Fundus photo; image size 2352x1568; 45° FOV: 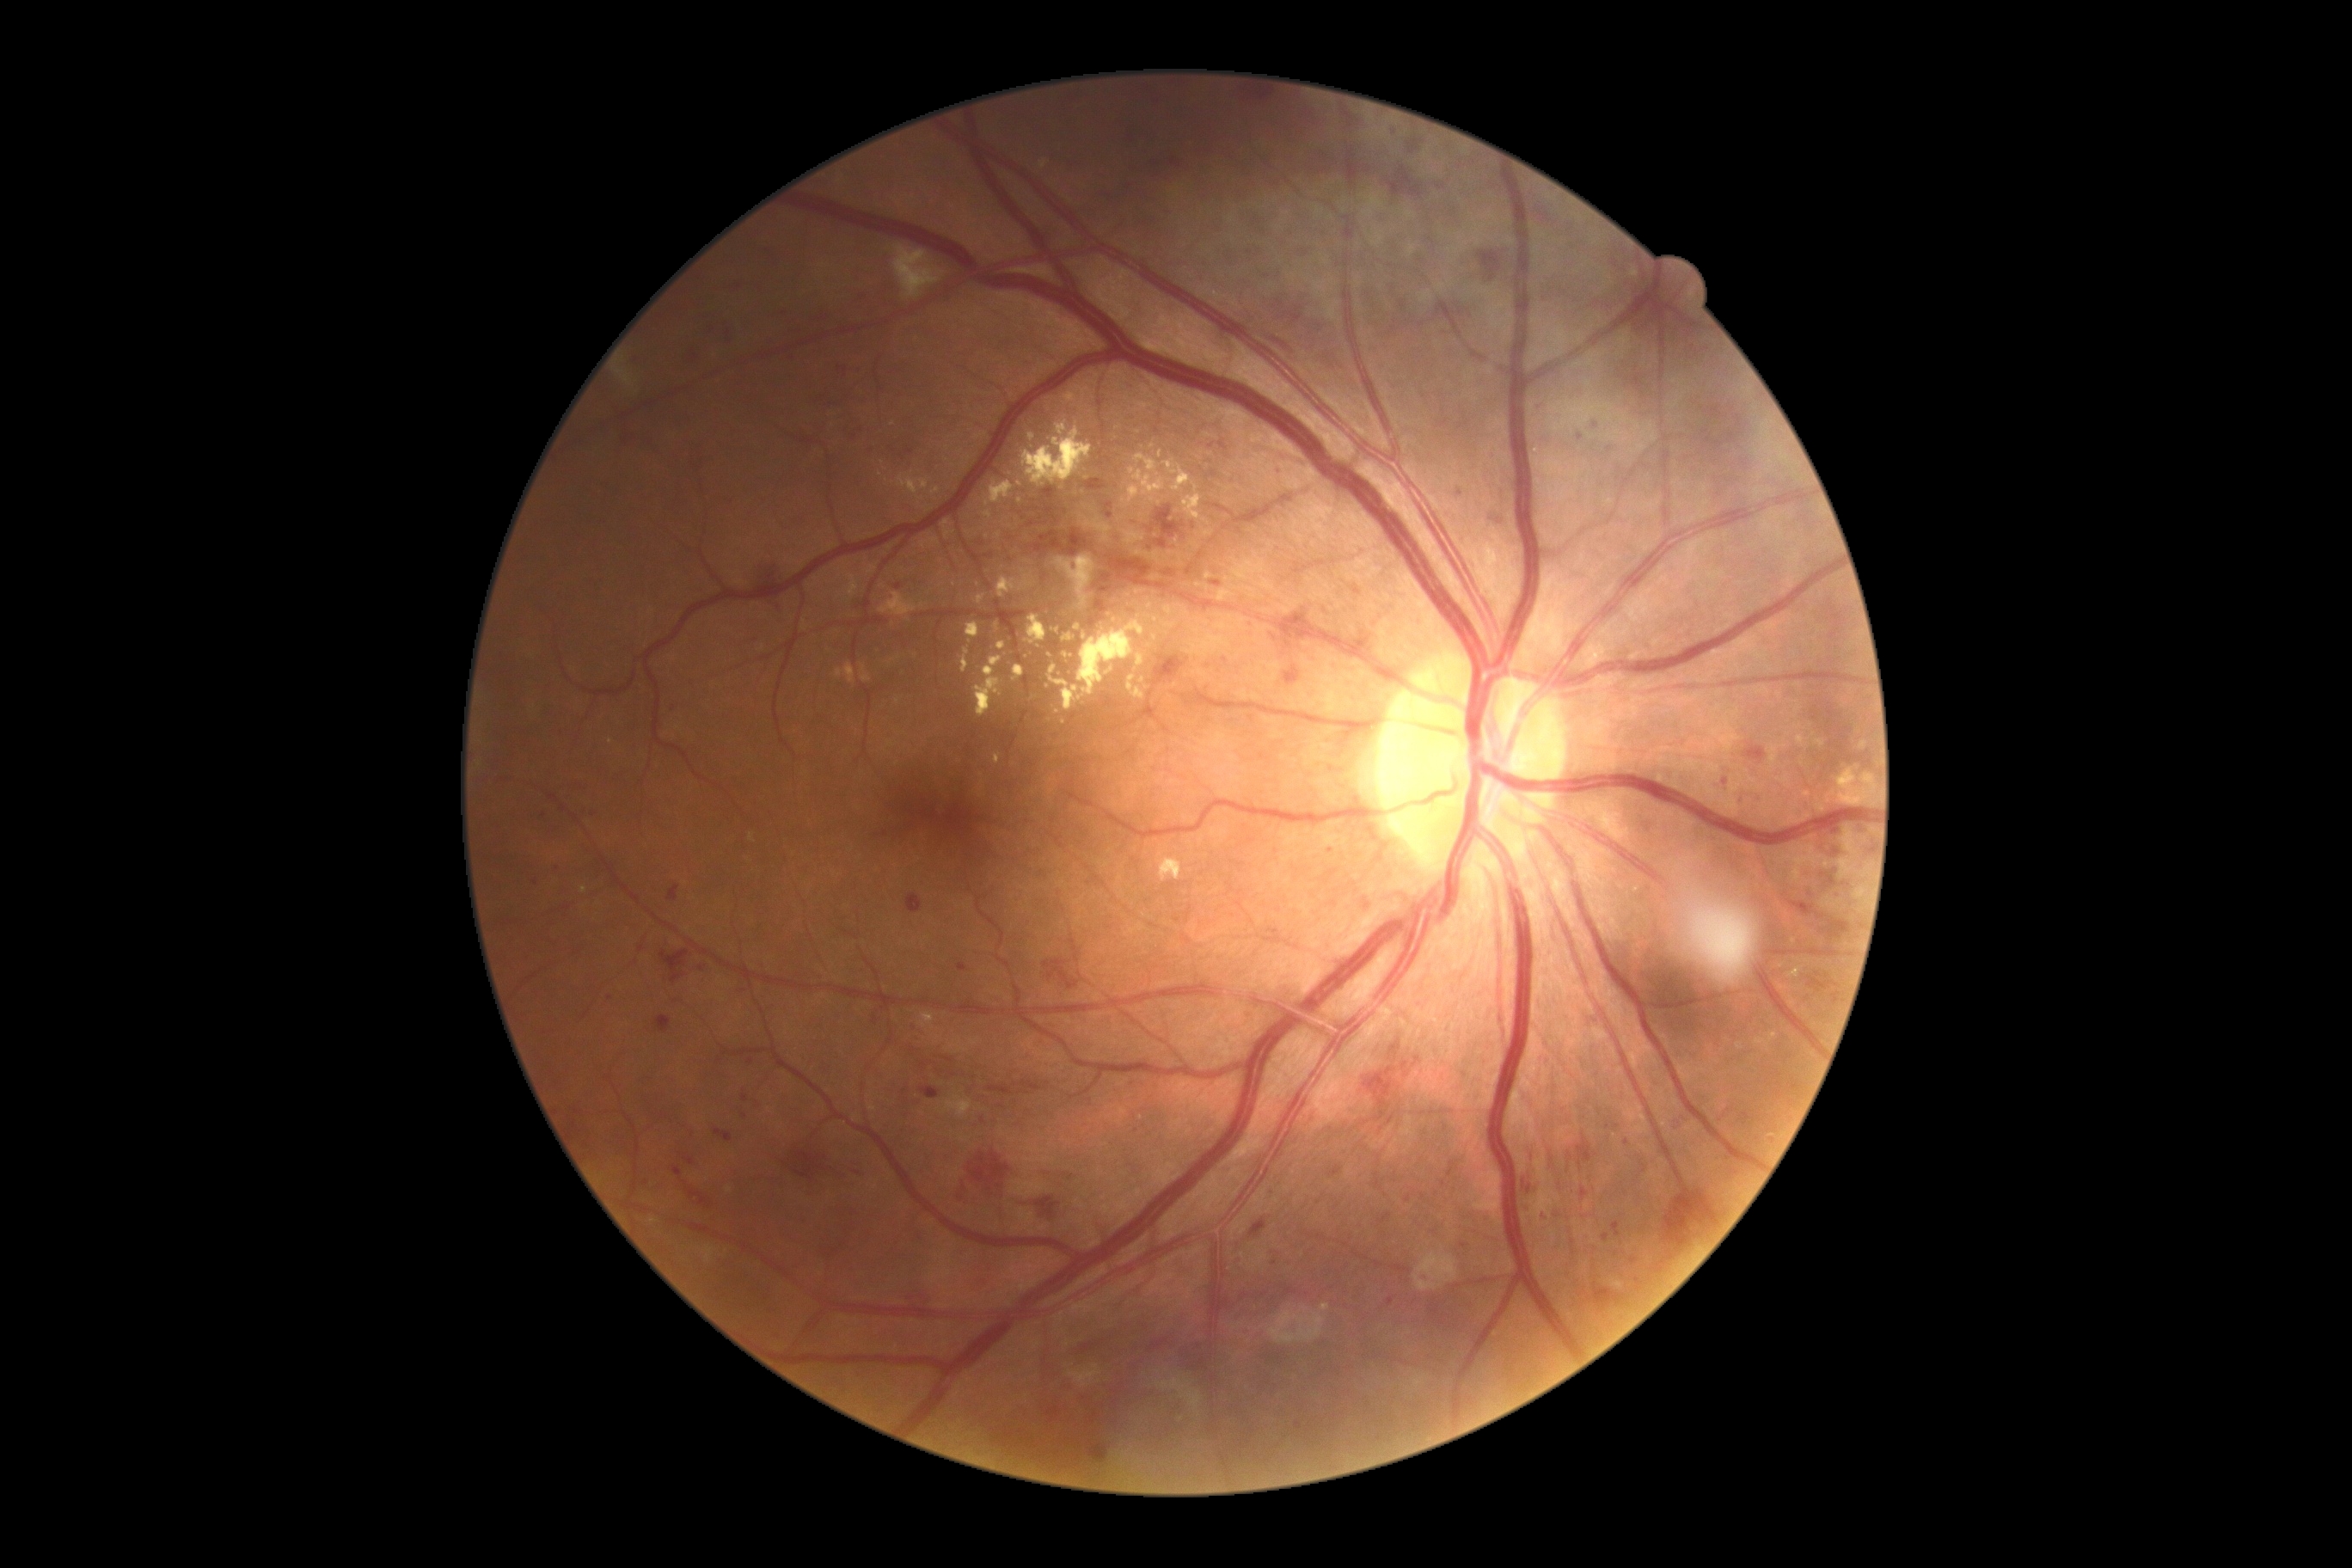
  dr_category: non-proliferative diabetic retinopathy
  dr_grade: moderate NPDR (grade 2)